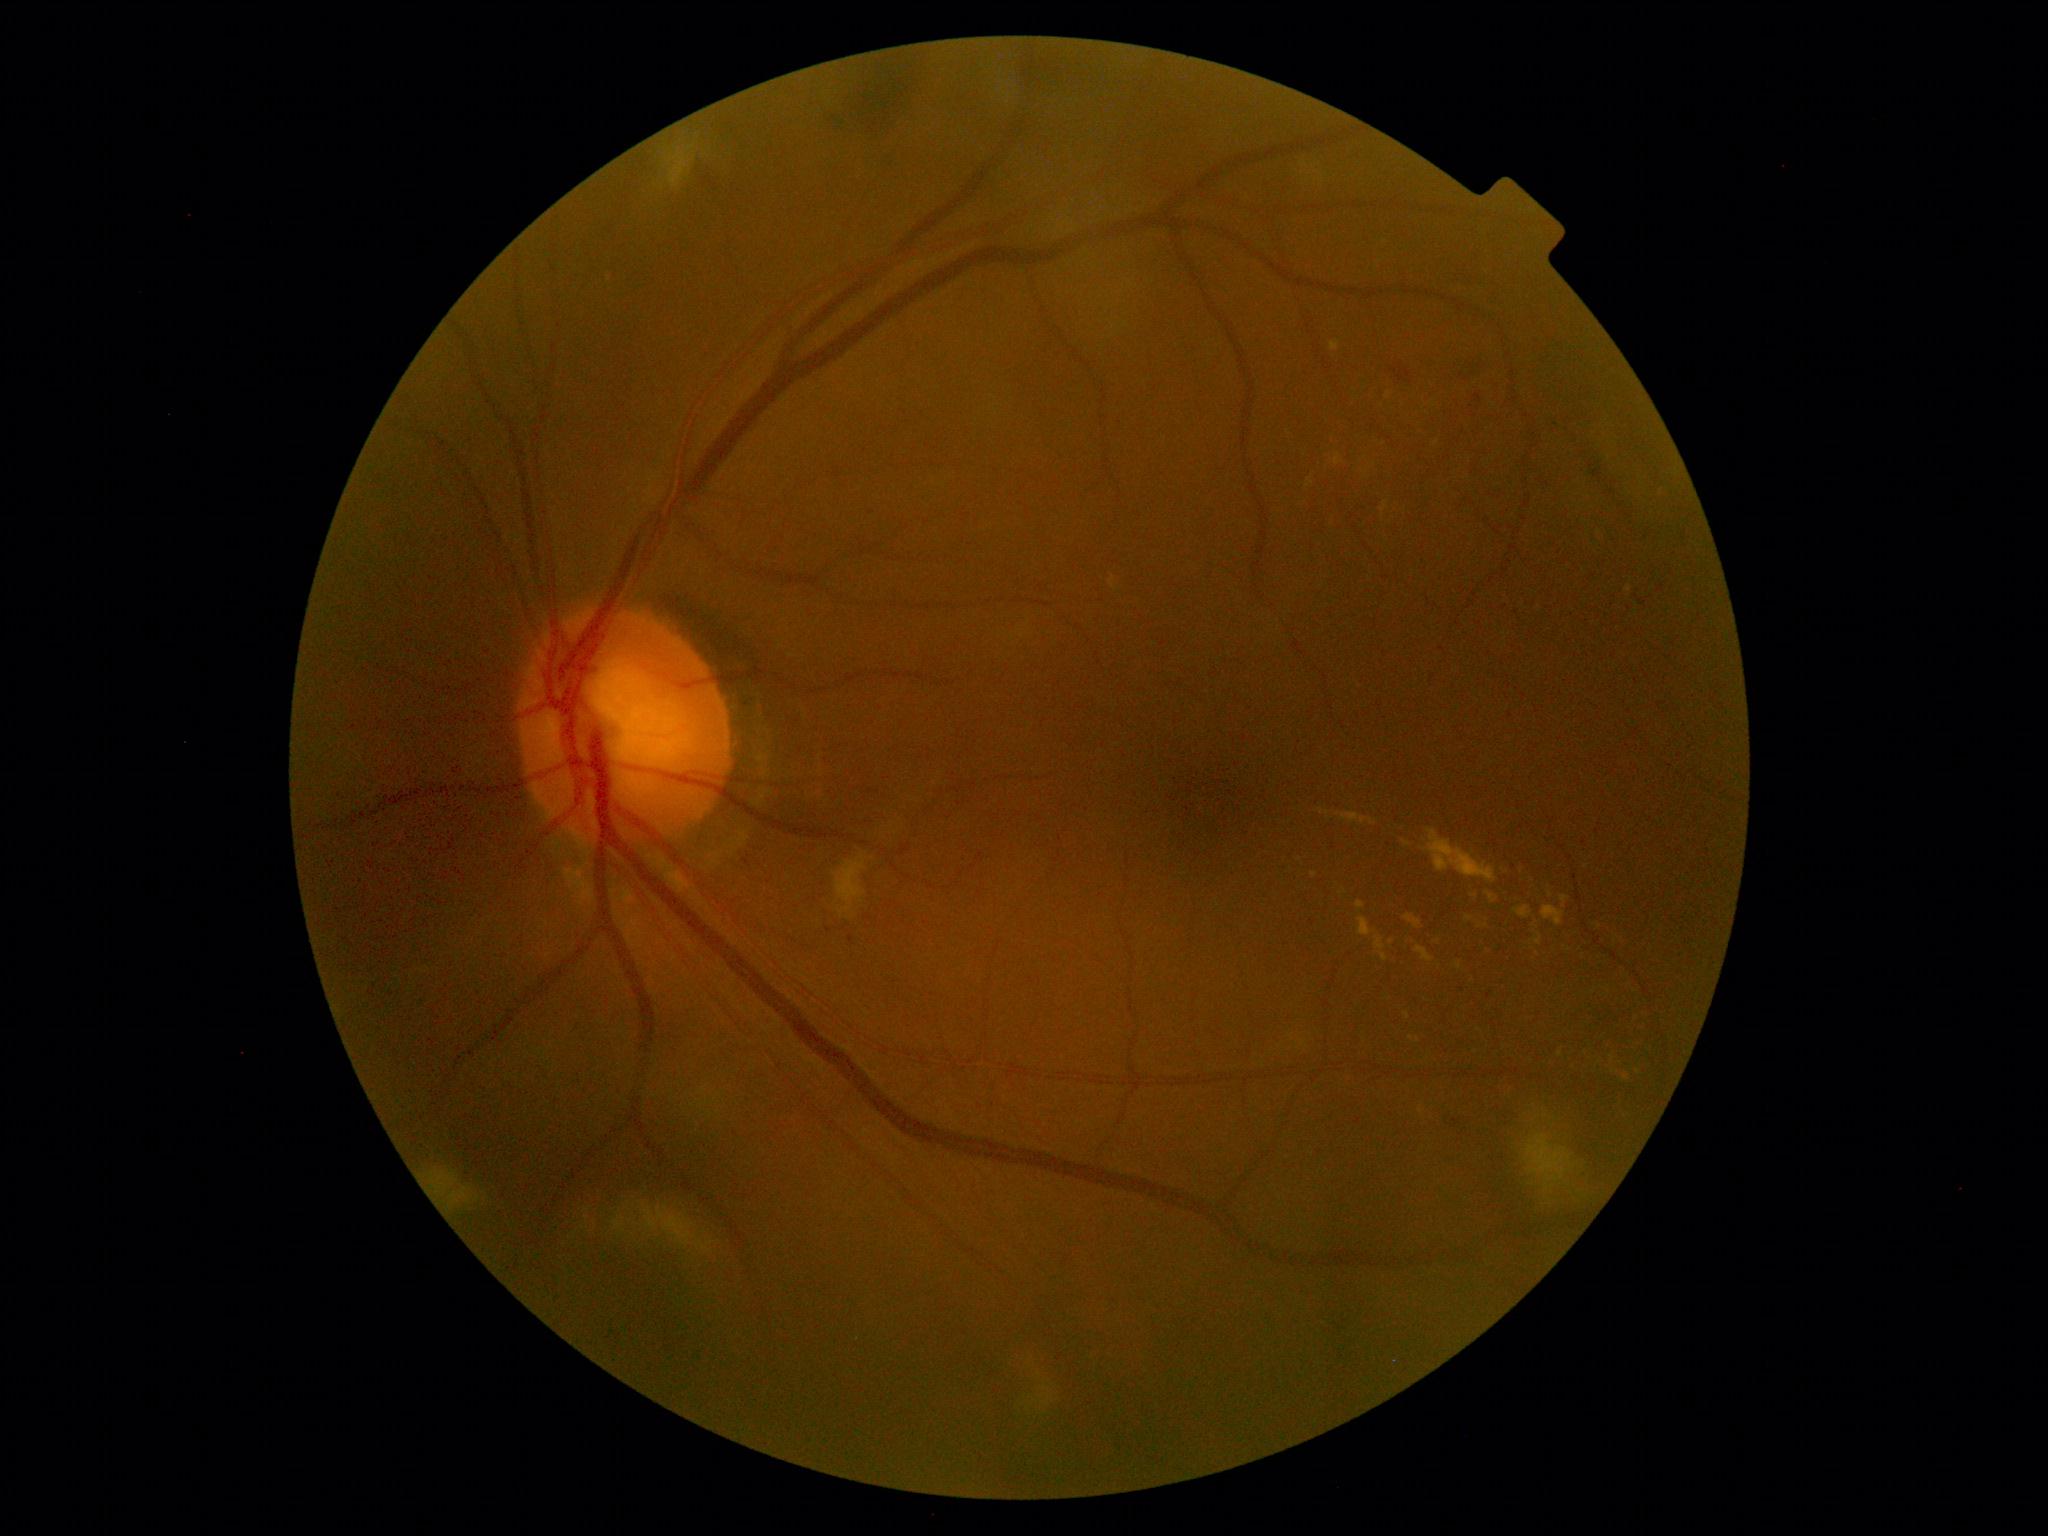
DR stage: 2/4 — more than just microaneurysms but less than severe NPDR.